45° field of view; CFP; 2212x1659px.
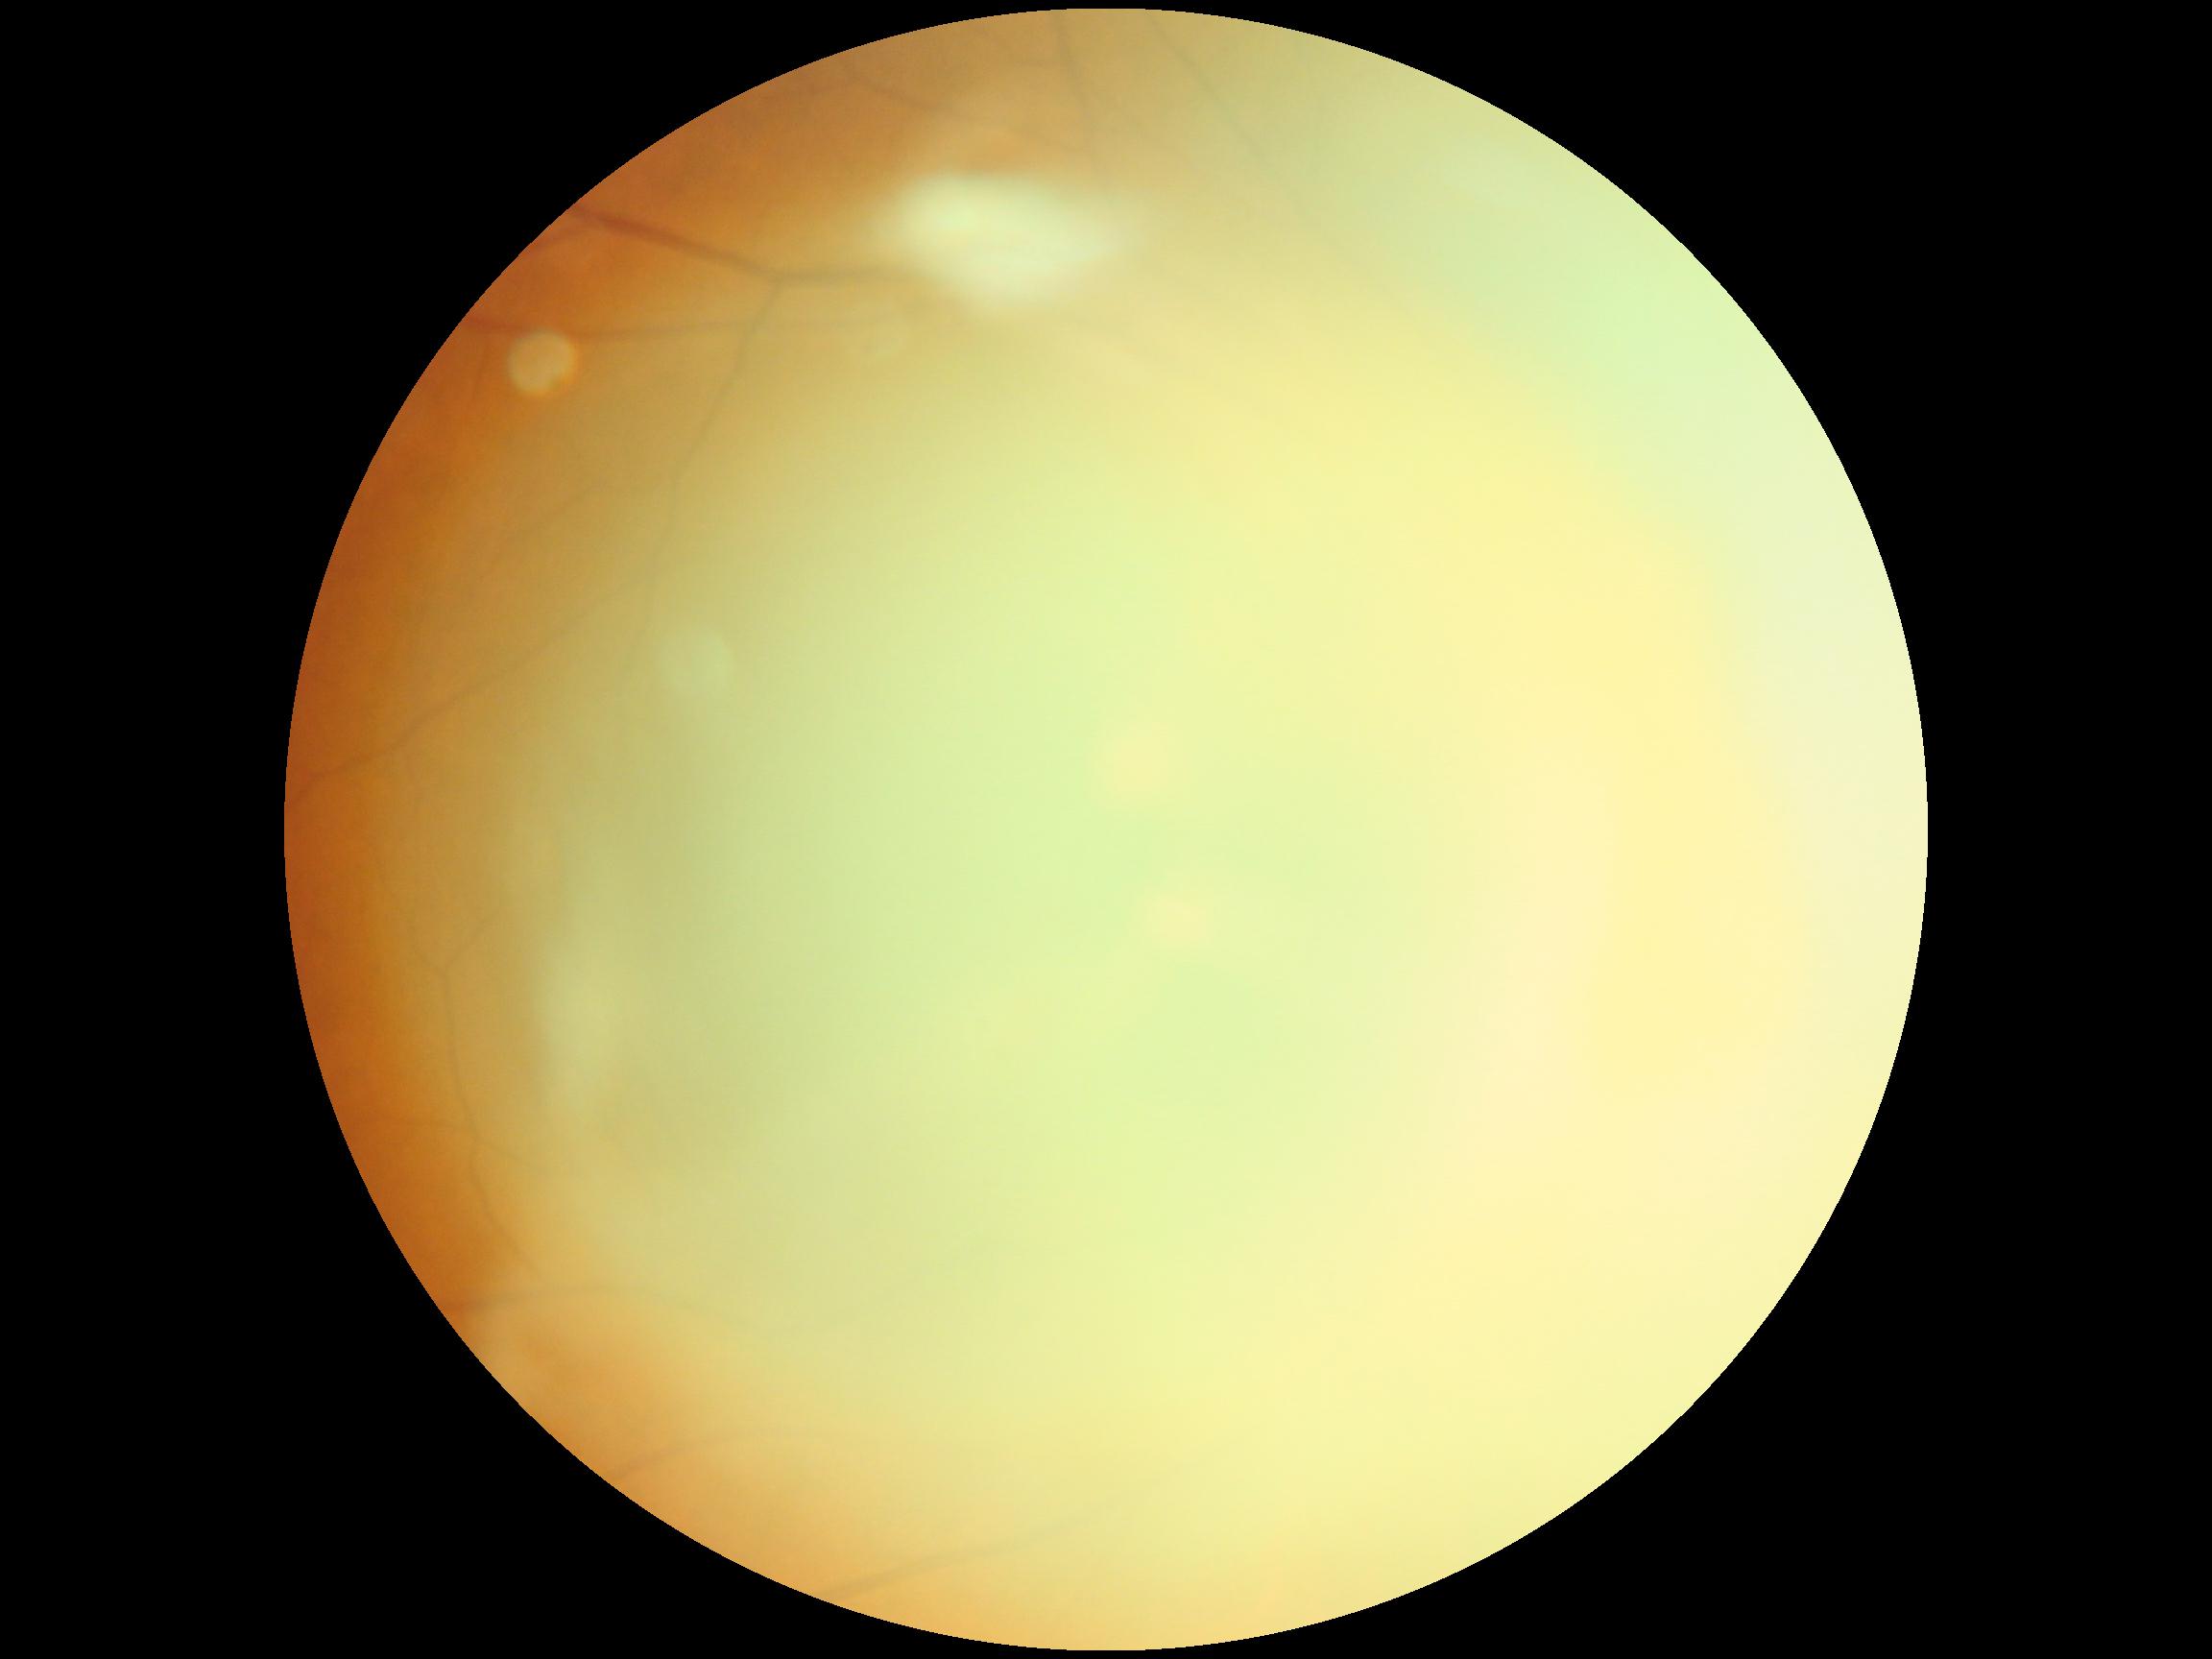
diabetic retinopathy = ungradable due to poor image quality.